130° field of view (Clarity RetCam 3) · wide-field fundus image from infant ROP screening
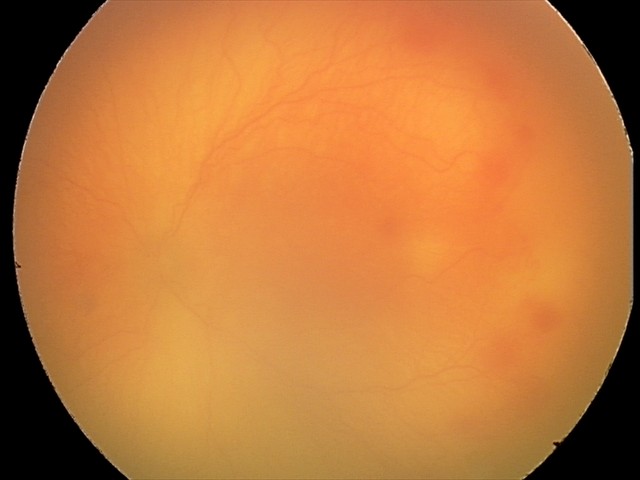 Q: What was the screening finding?
A: aggressive ROP (A-ROP)